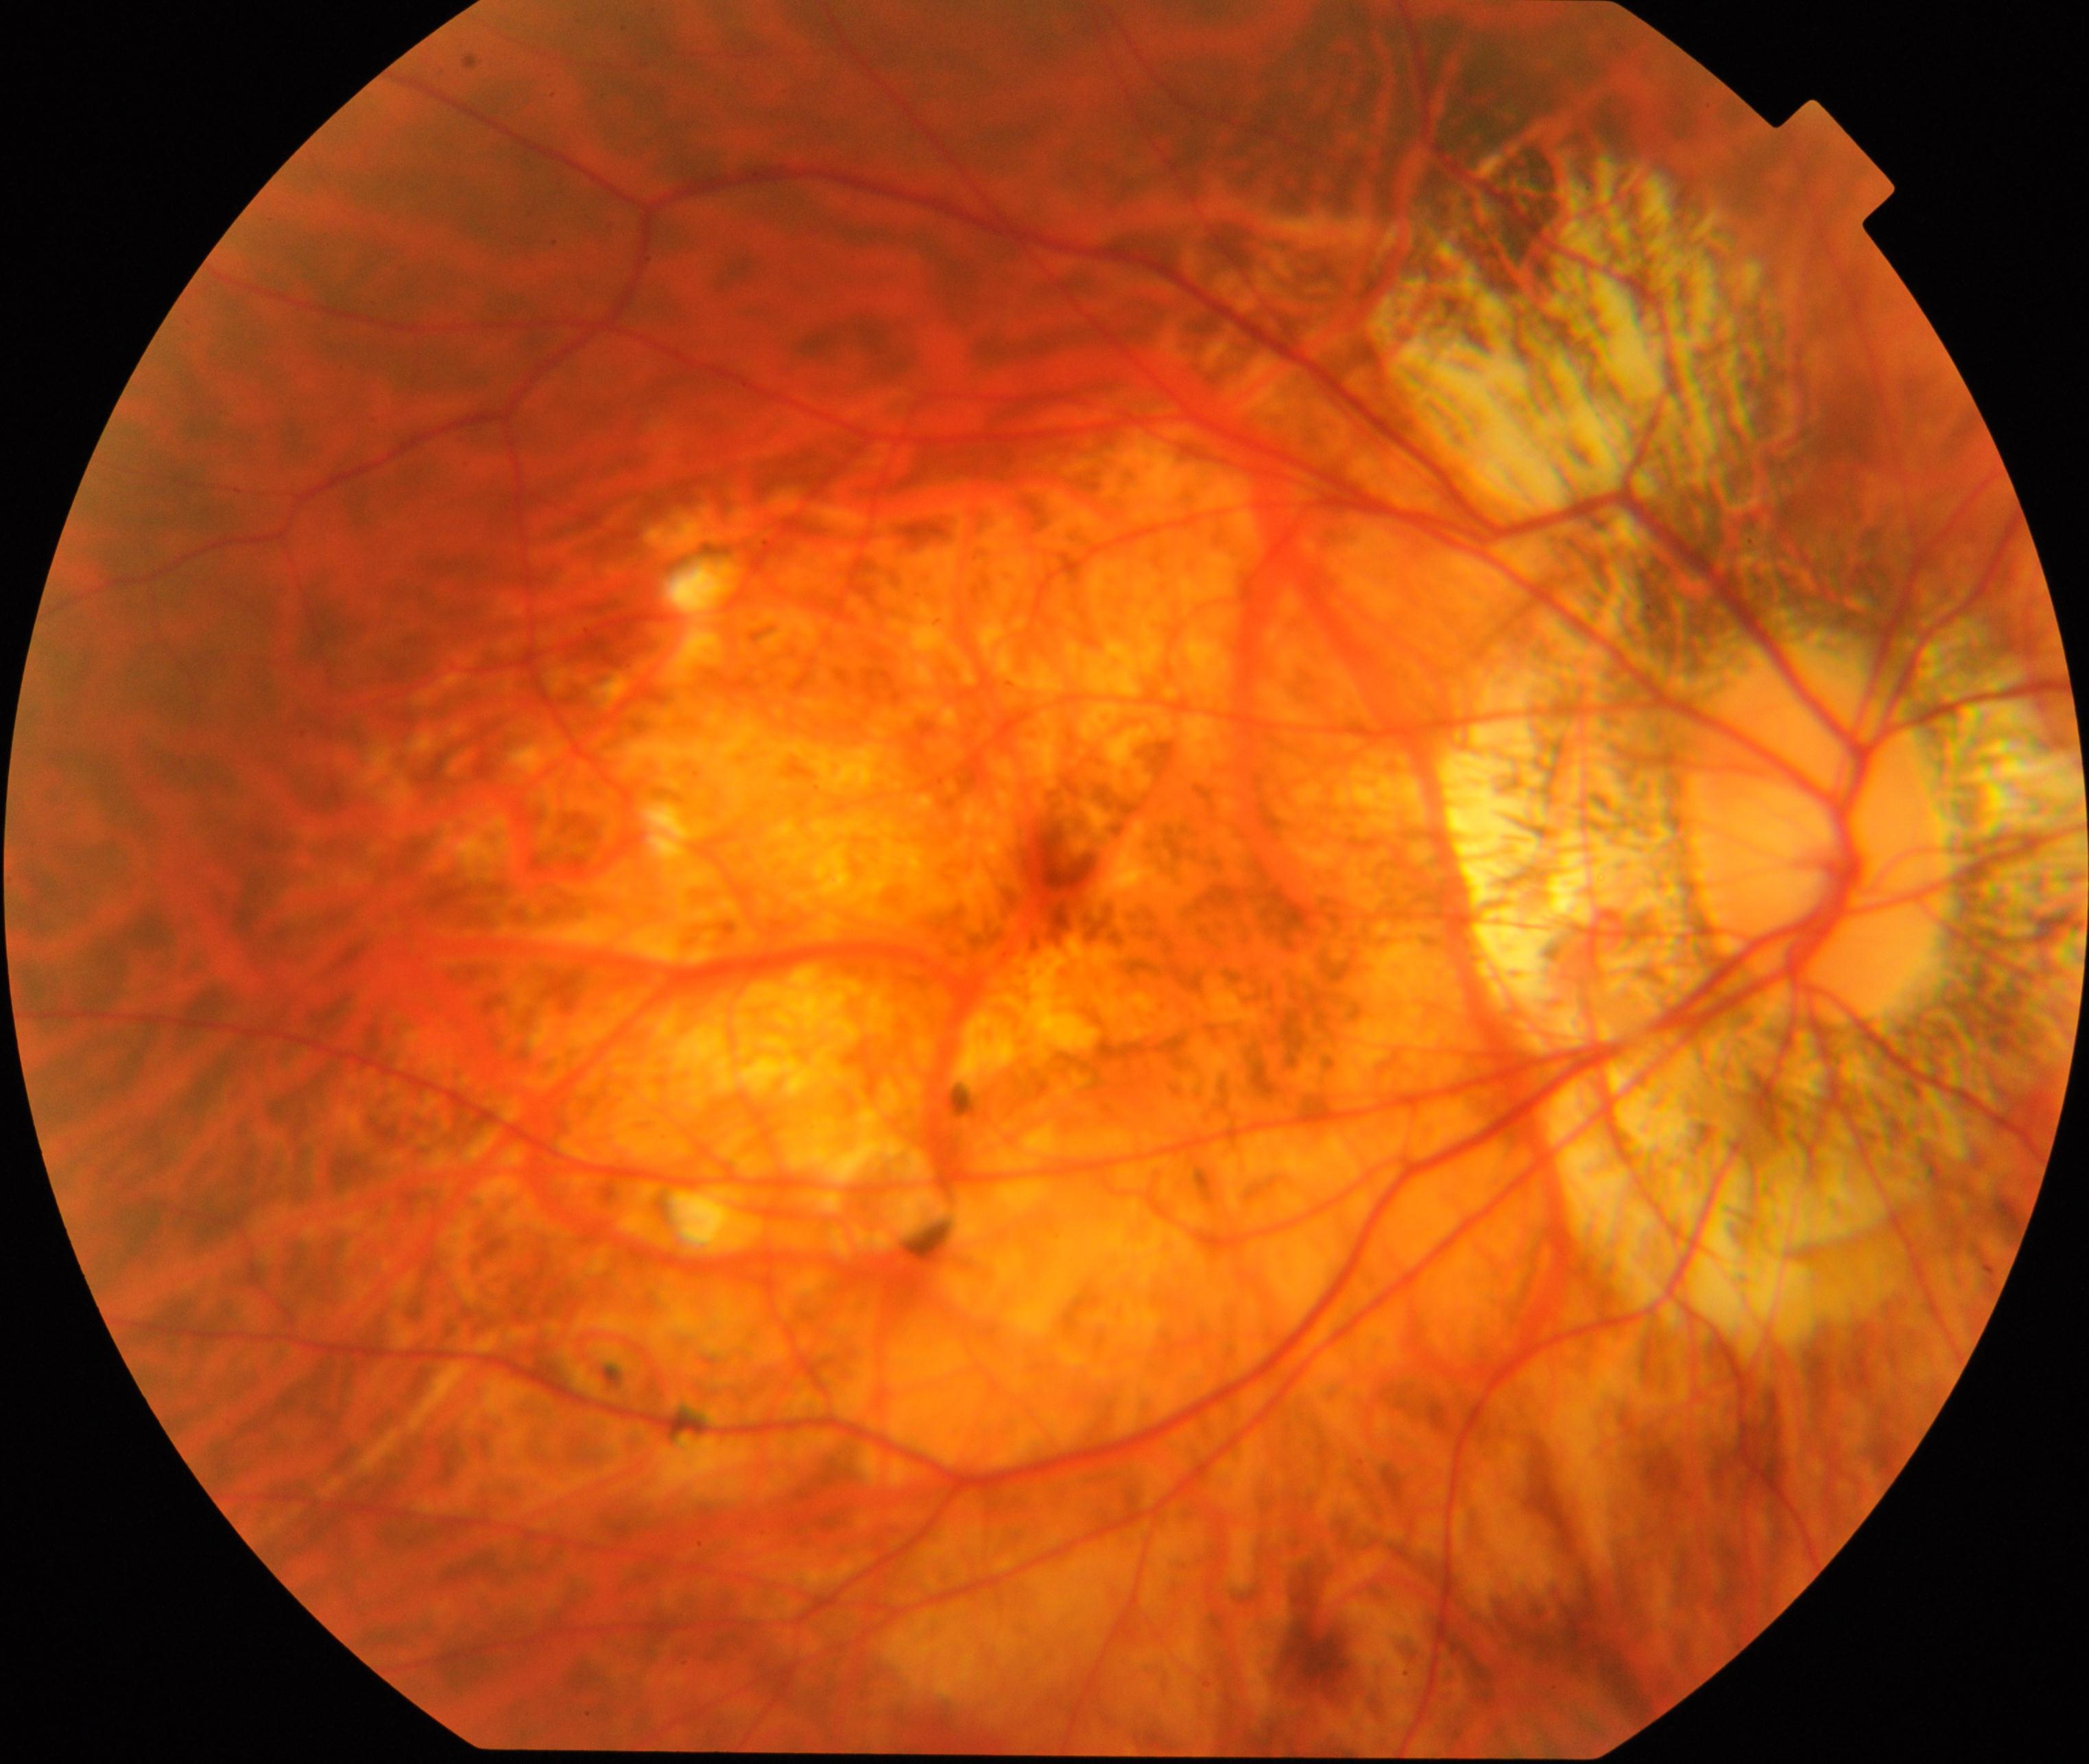

Findings: pathological myopia.